2352 by 1568 pixels.
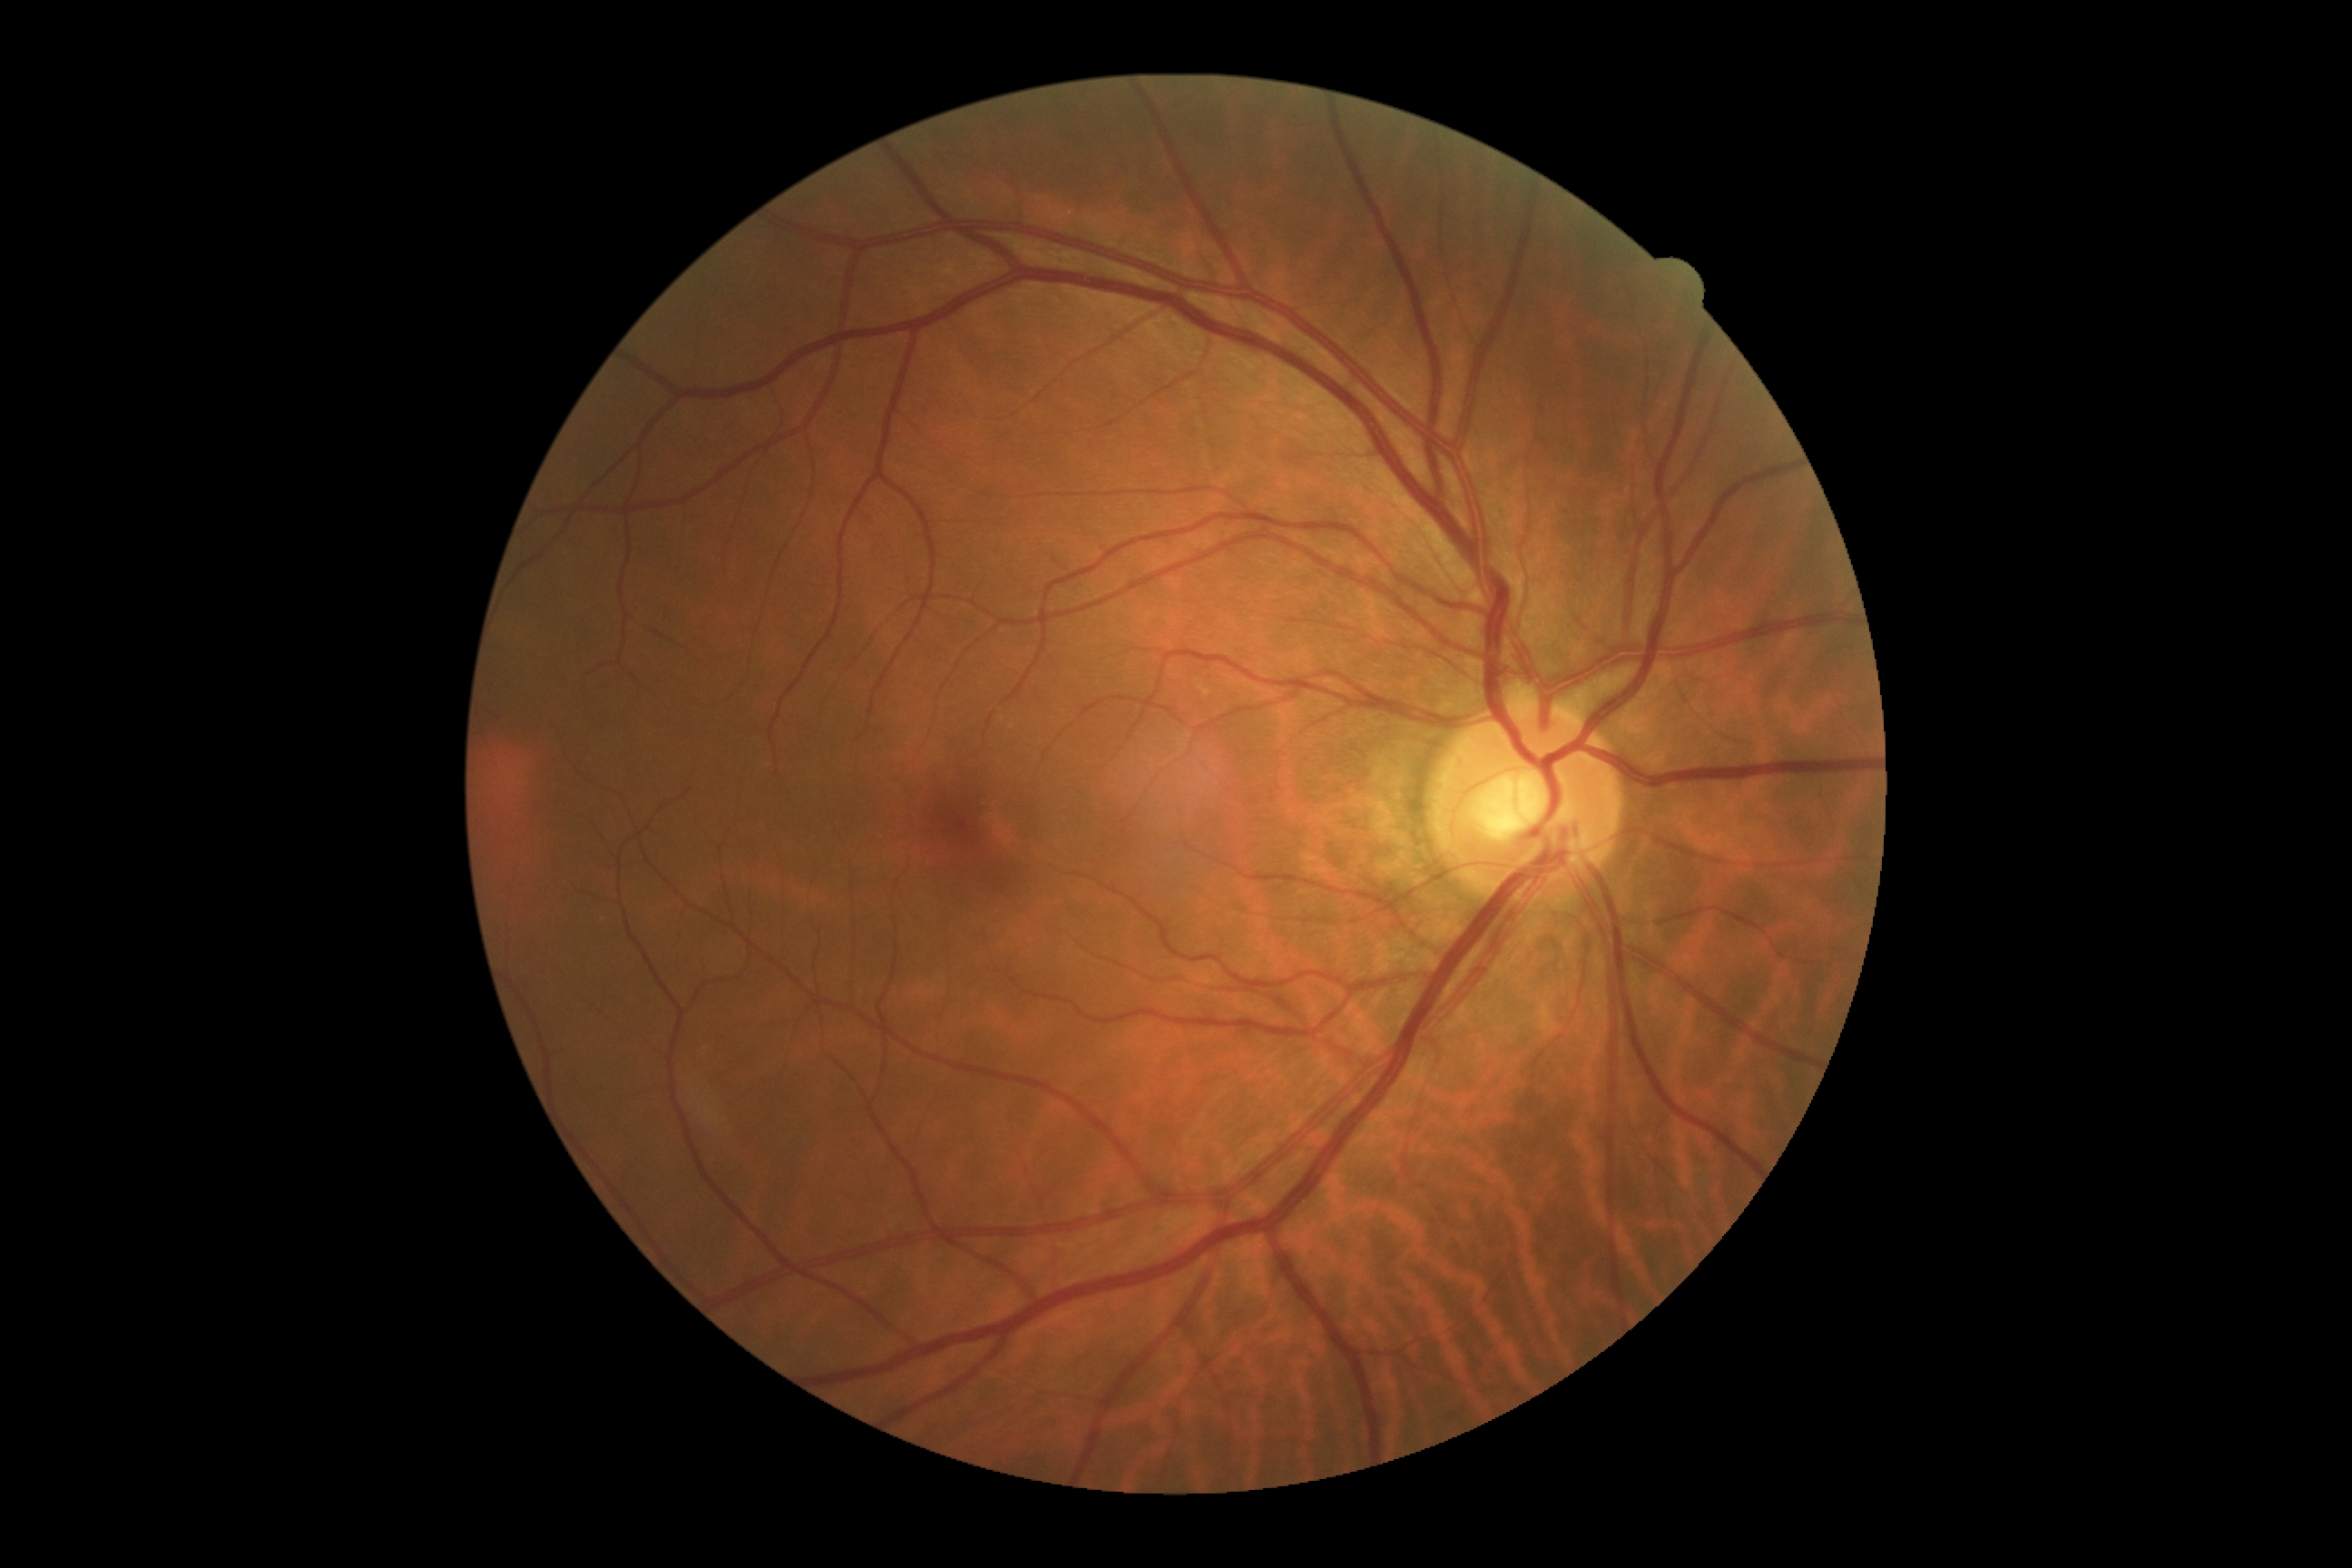 retinopathy: grade 0 (no apparent retinopathy)